NIDEK AFC-230, 848x848.
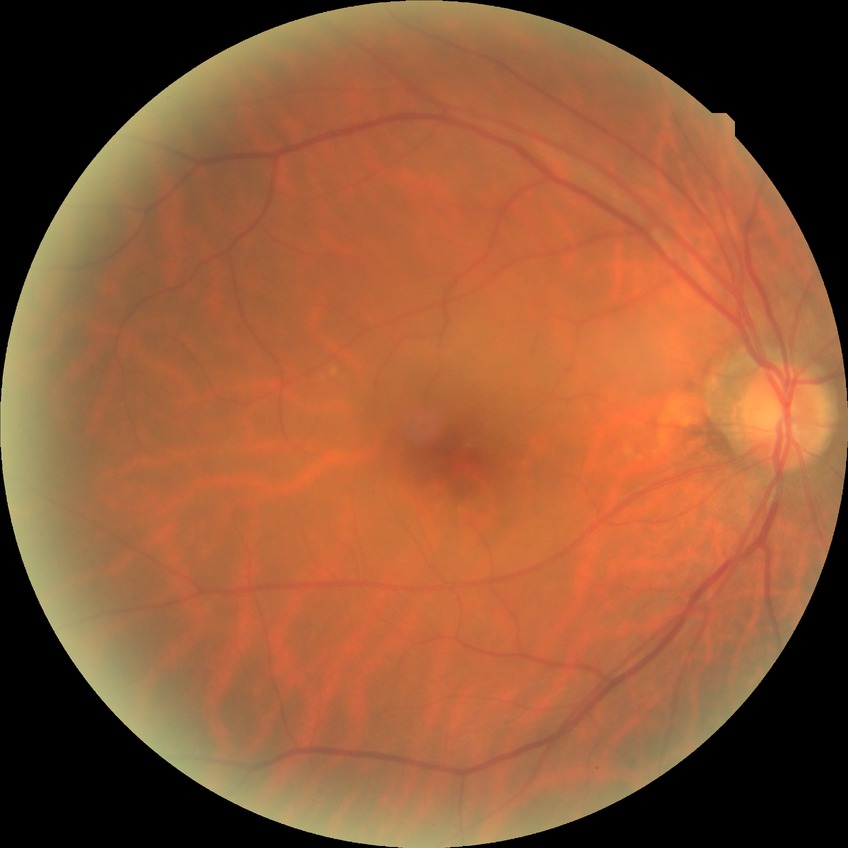 Diabetic retinopathy (DR): NDR (no diabetic retinopathy).